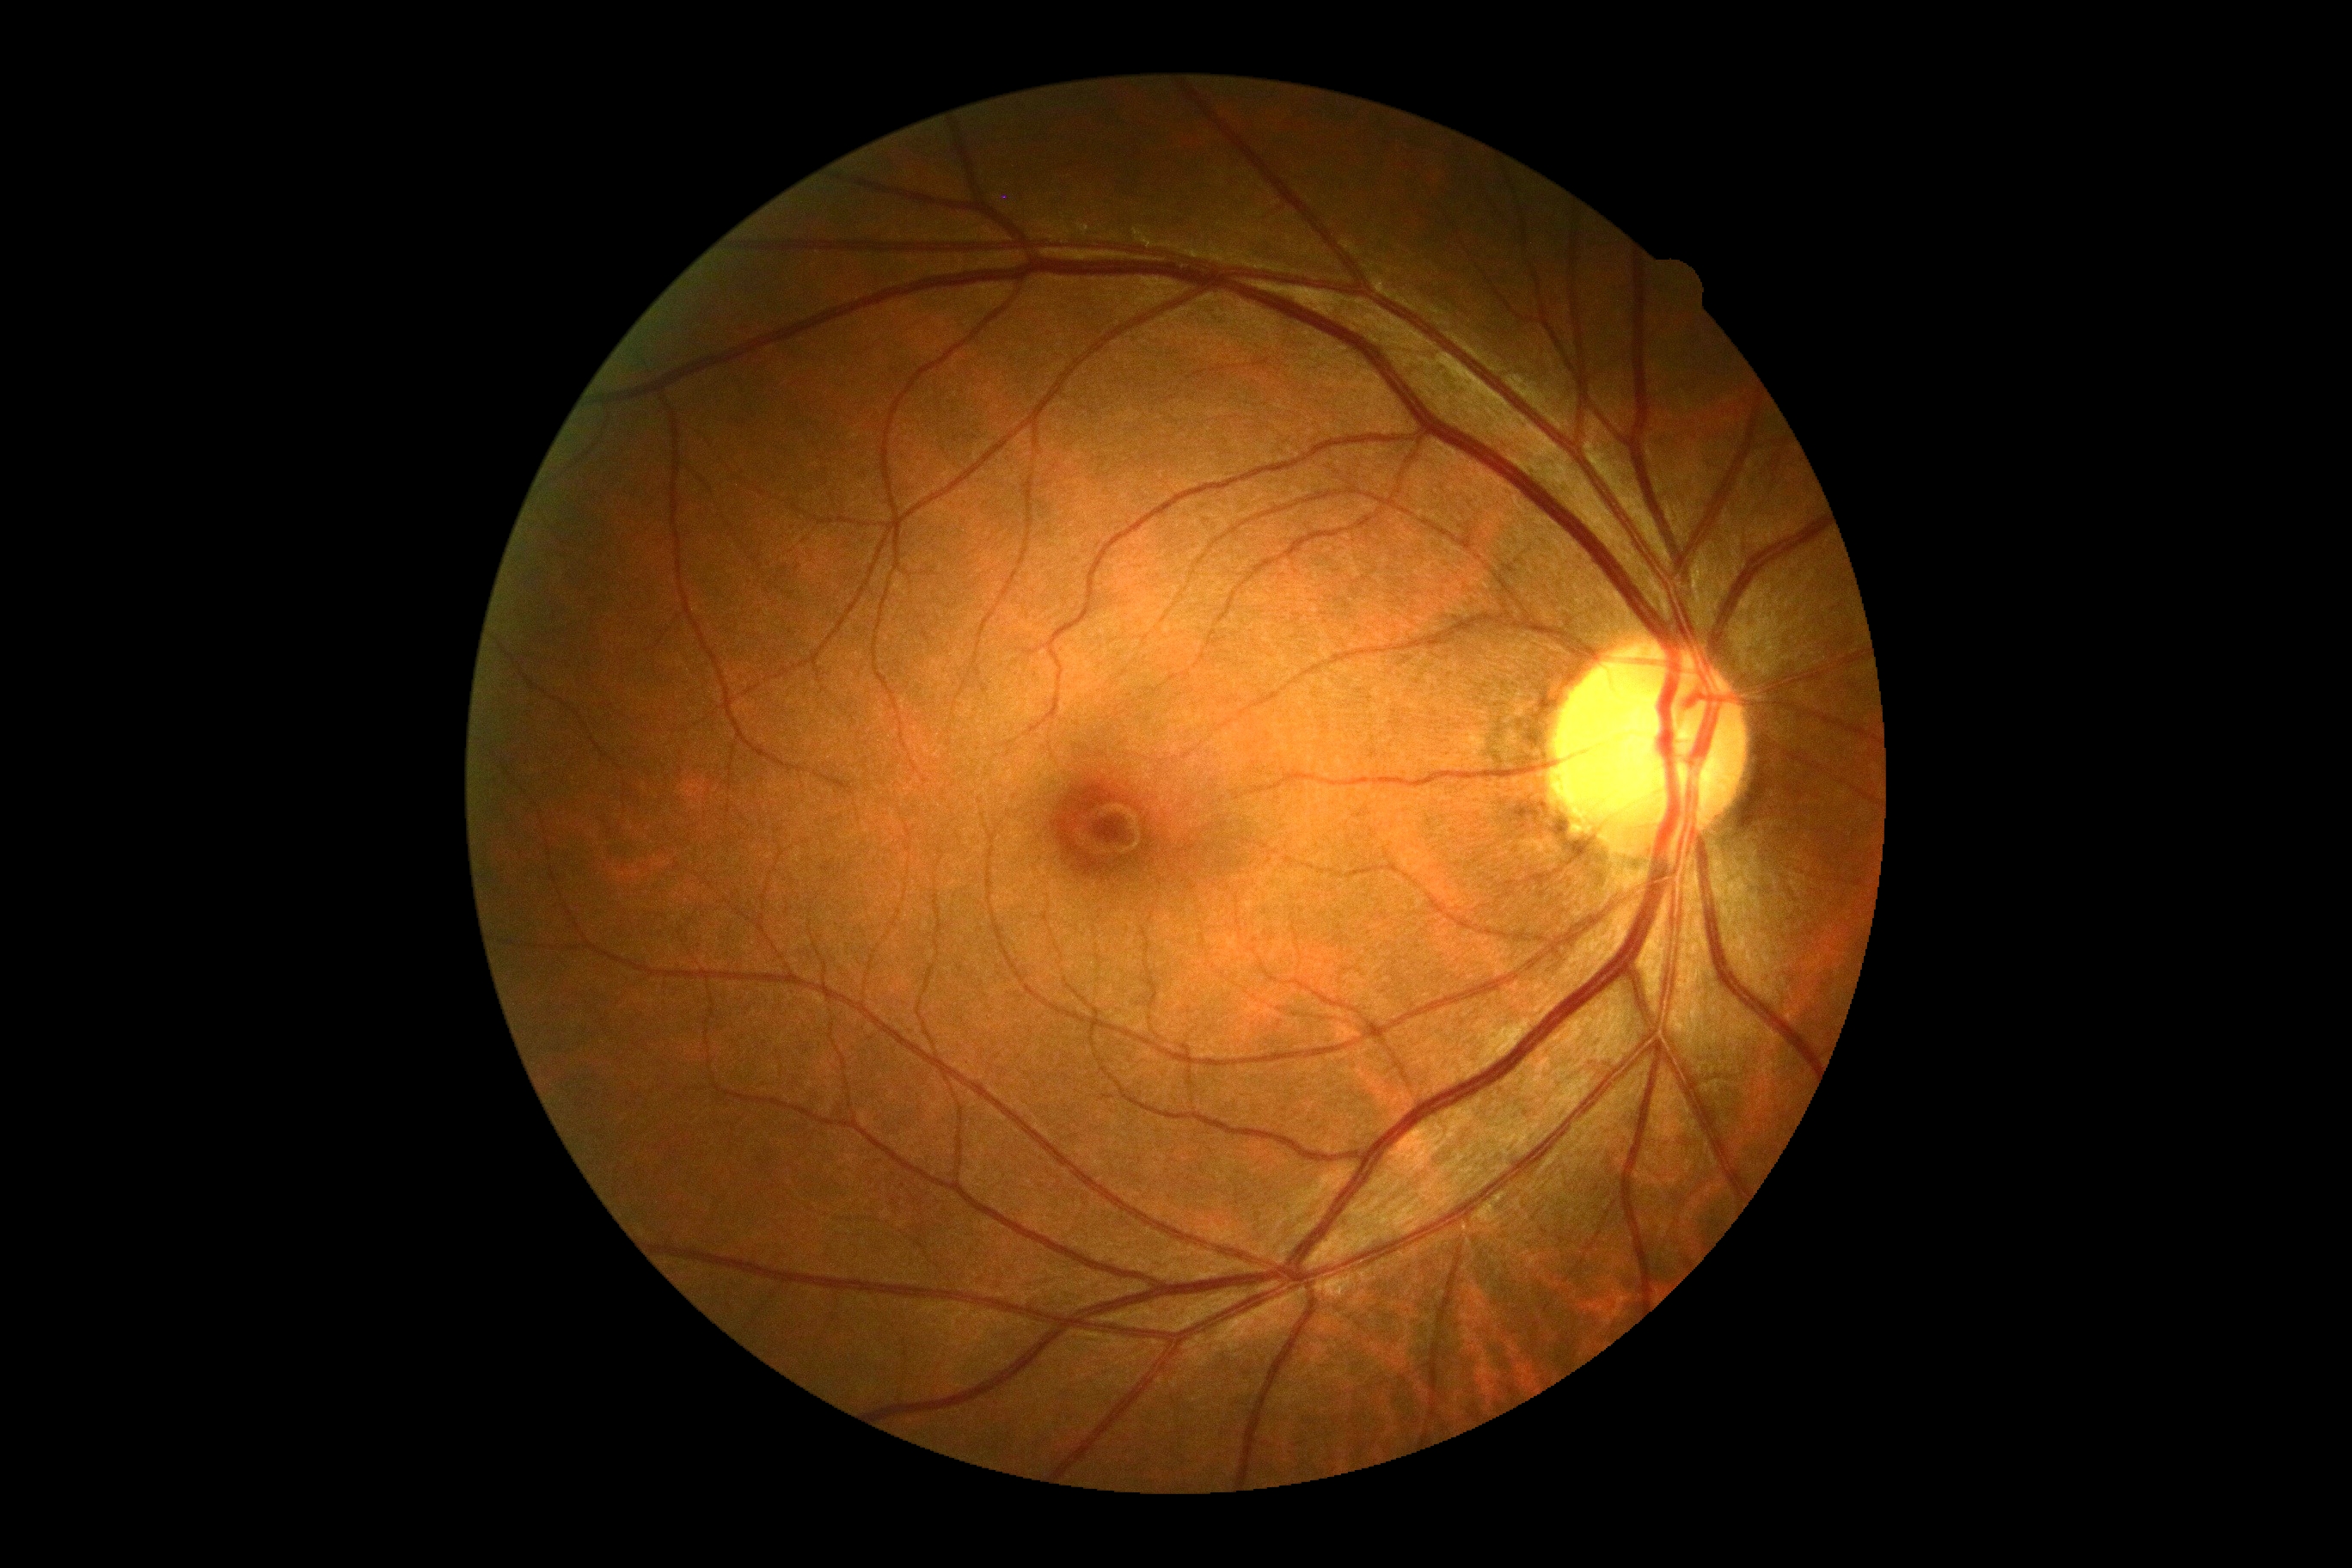 Annotations:
- DR impression — no apparent DR
- DR severity — grade 0 (no apparent retinopathy)